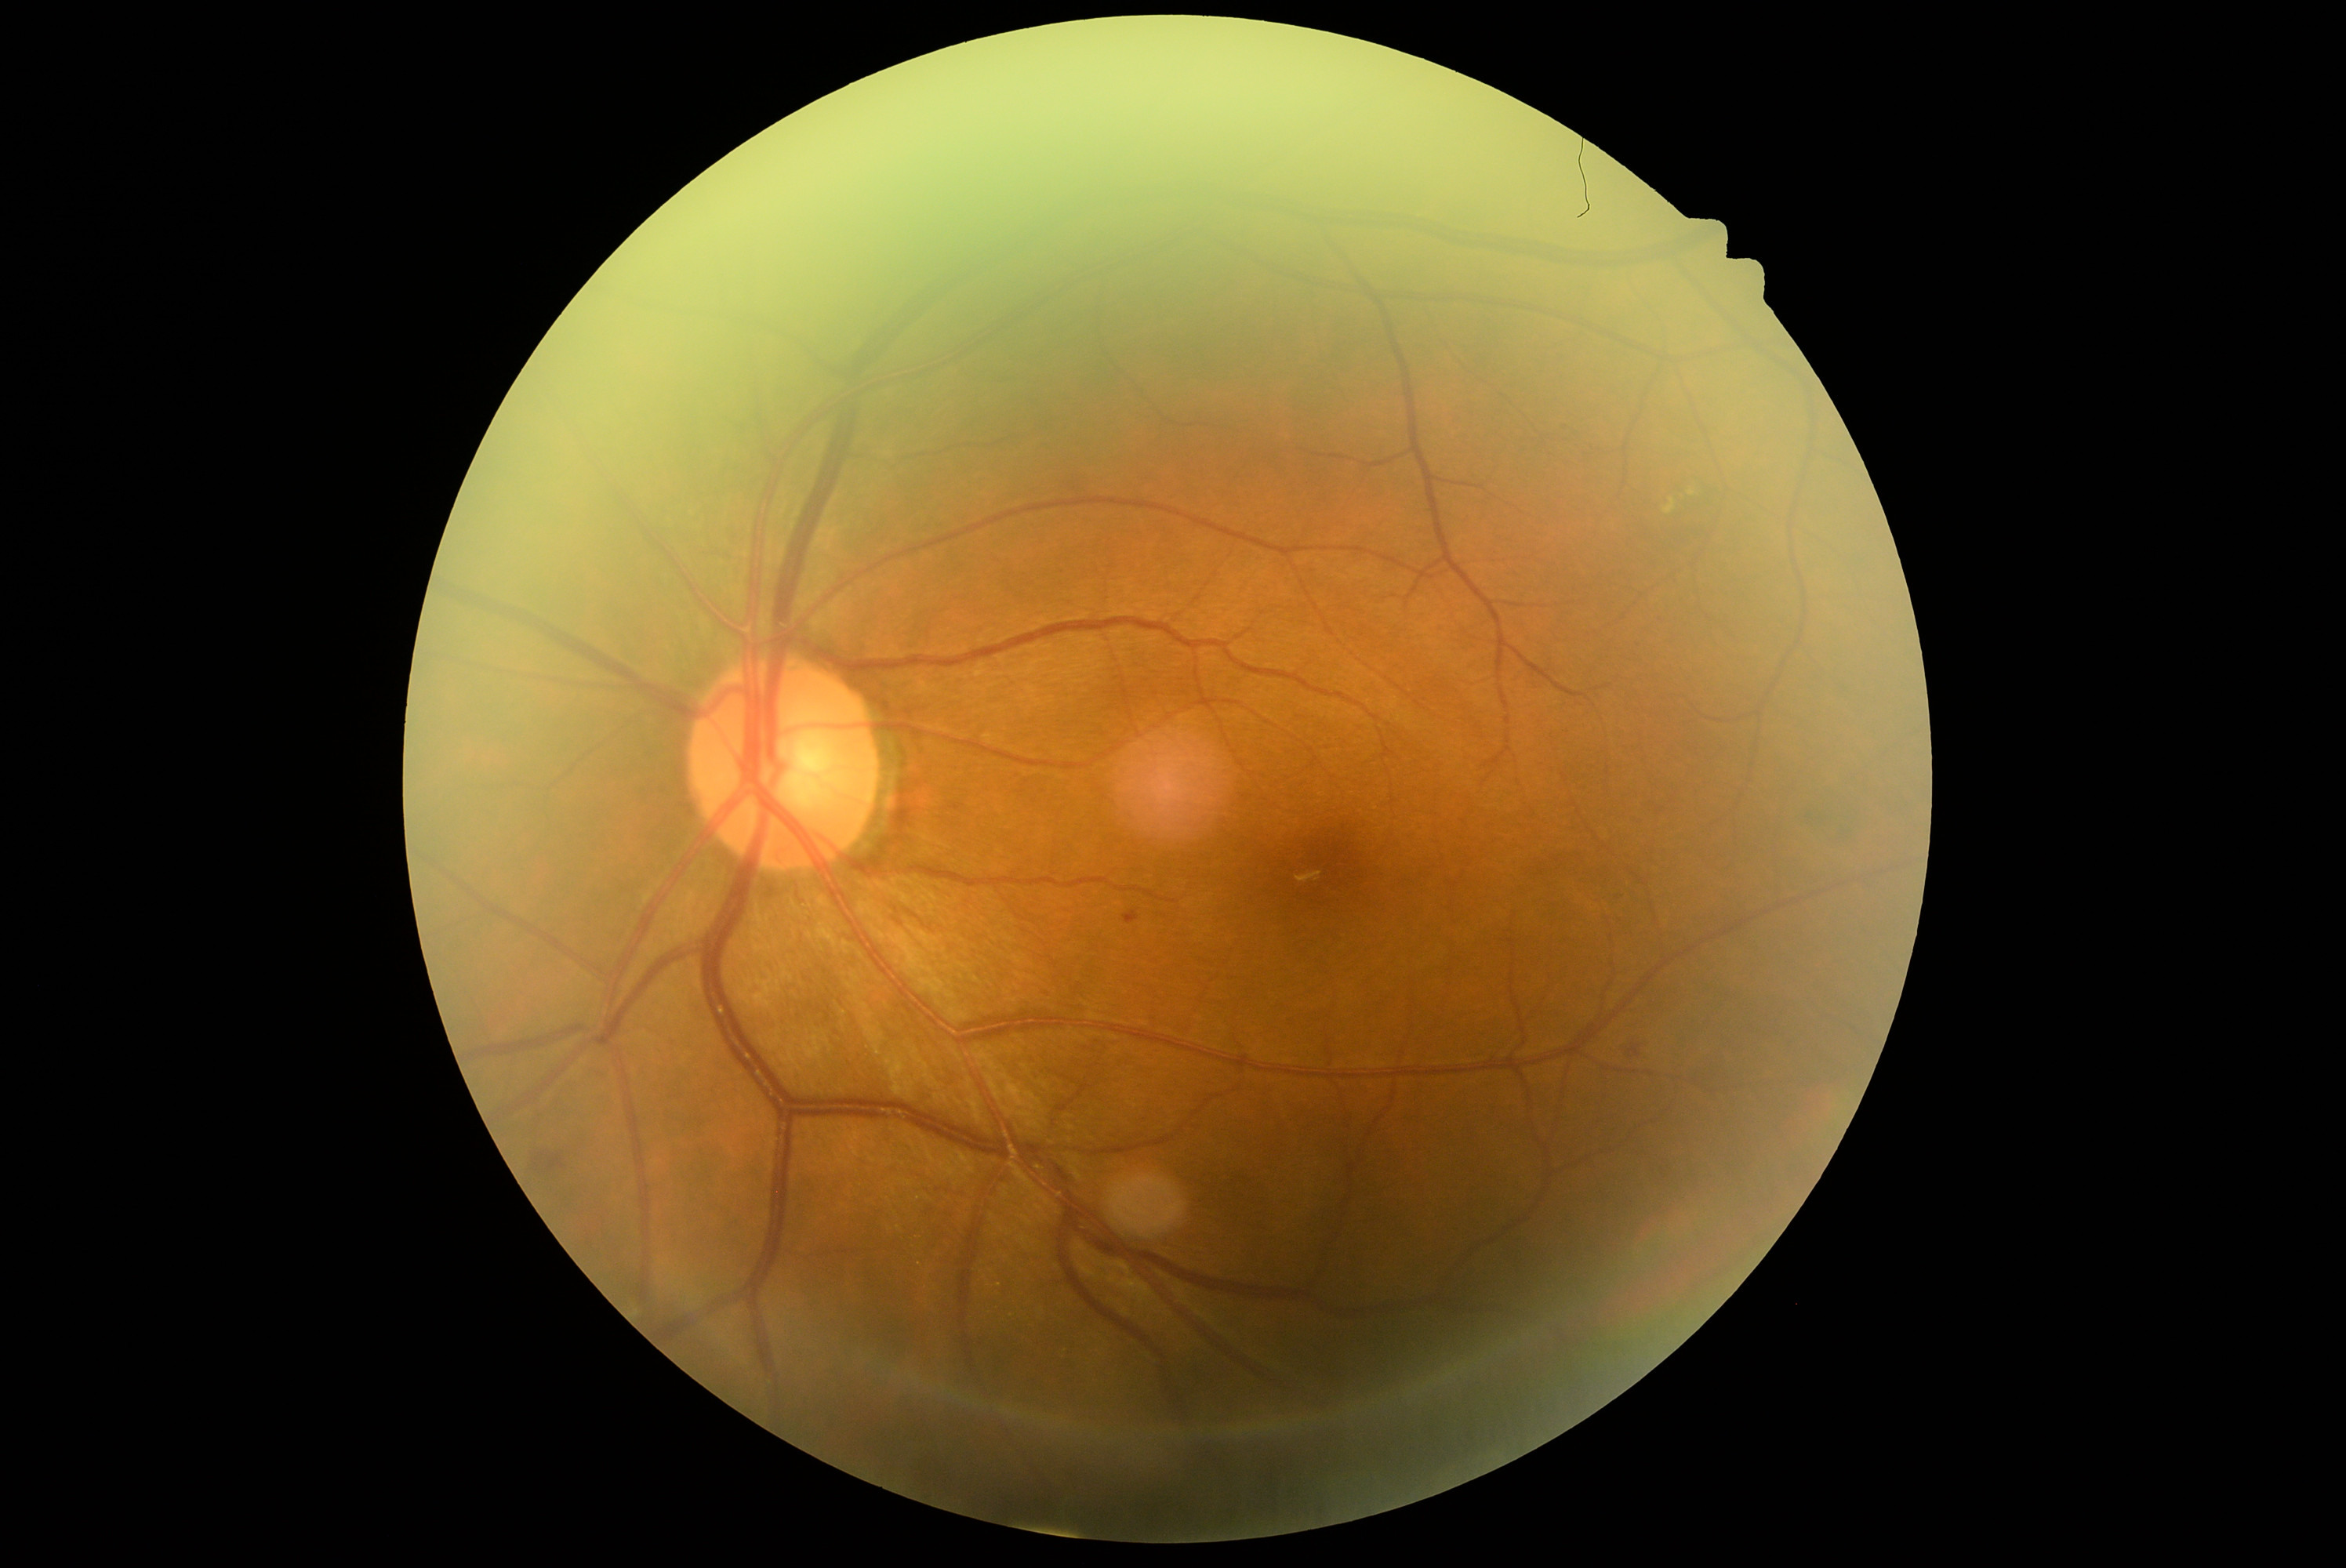
  dr_grade: grade 2 (moderate NPDR)